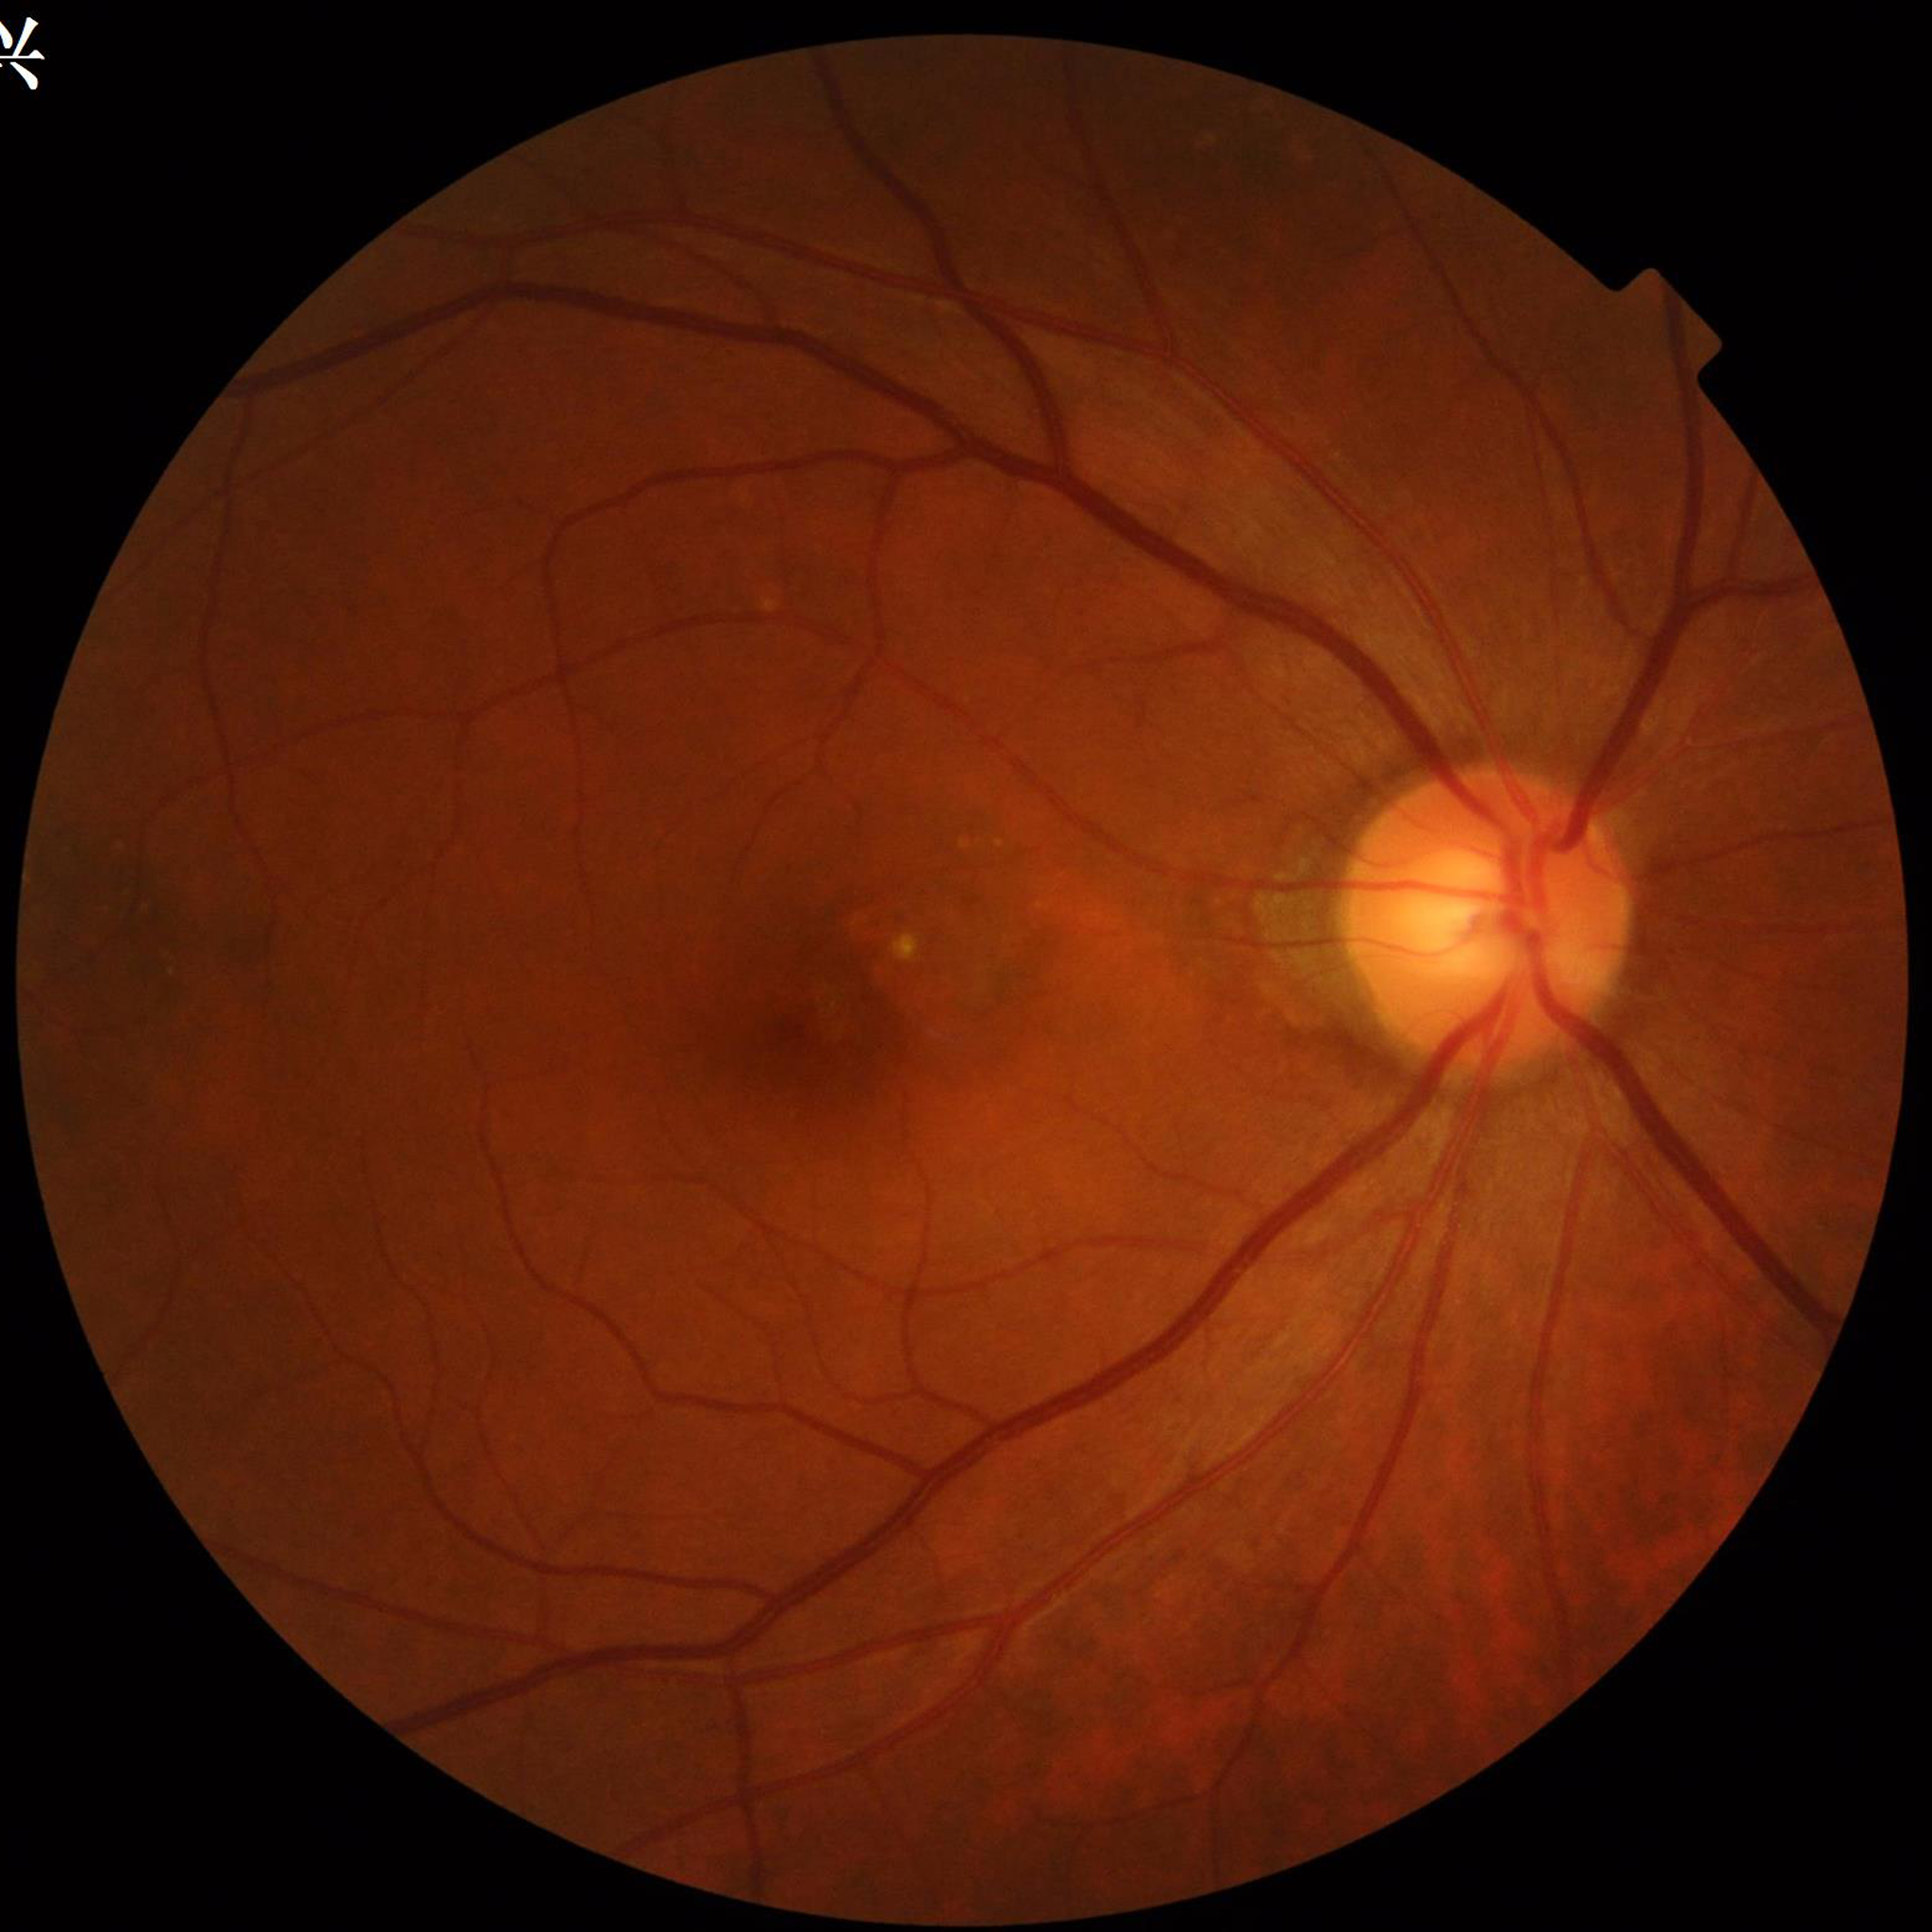
Patient diagnosed with AMD.